Fundus photo, camera: Nidek AFC-330: 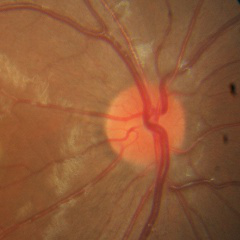
Showing no glaucomatous changes.